FOV: 45 degrees; 2212x1659px — 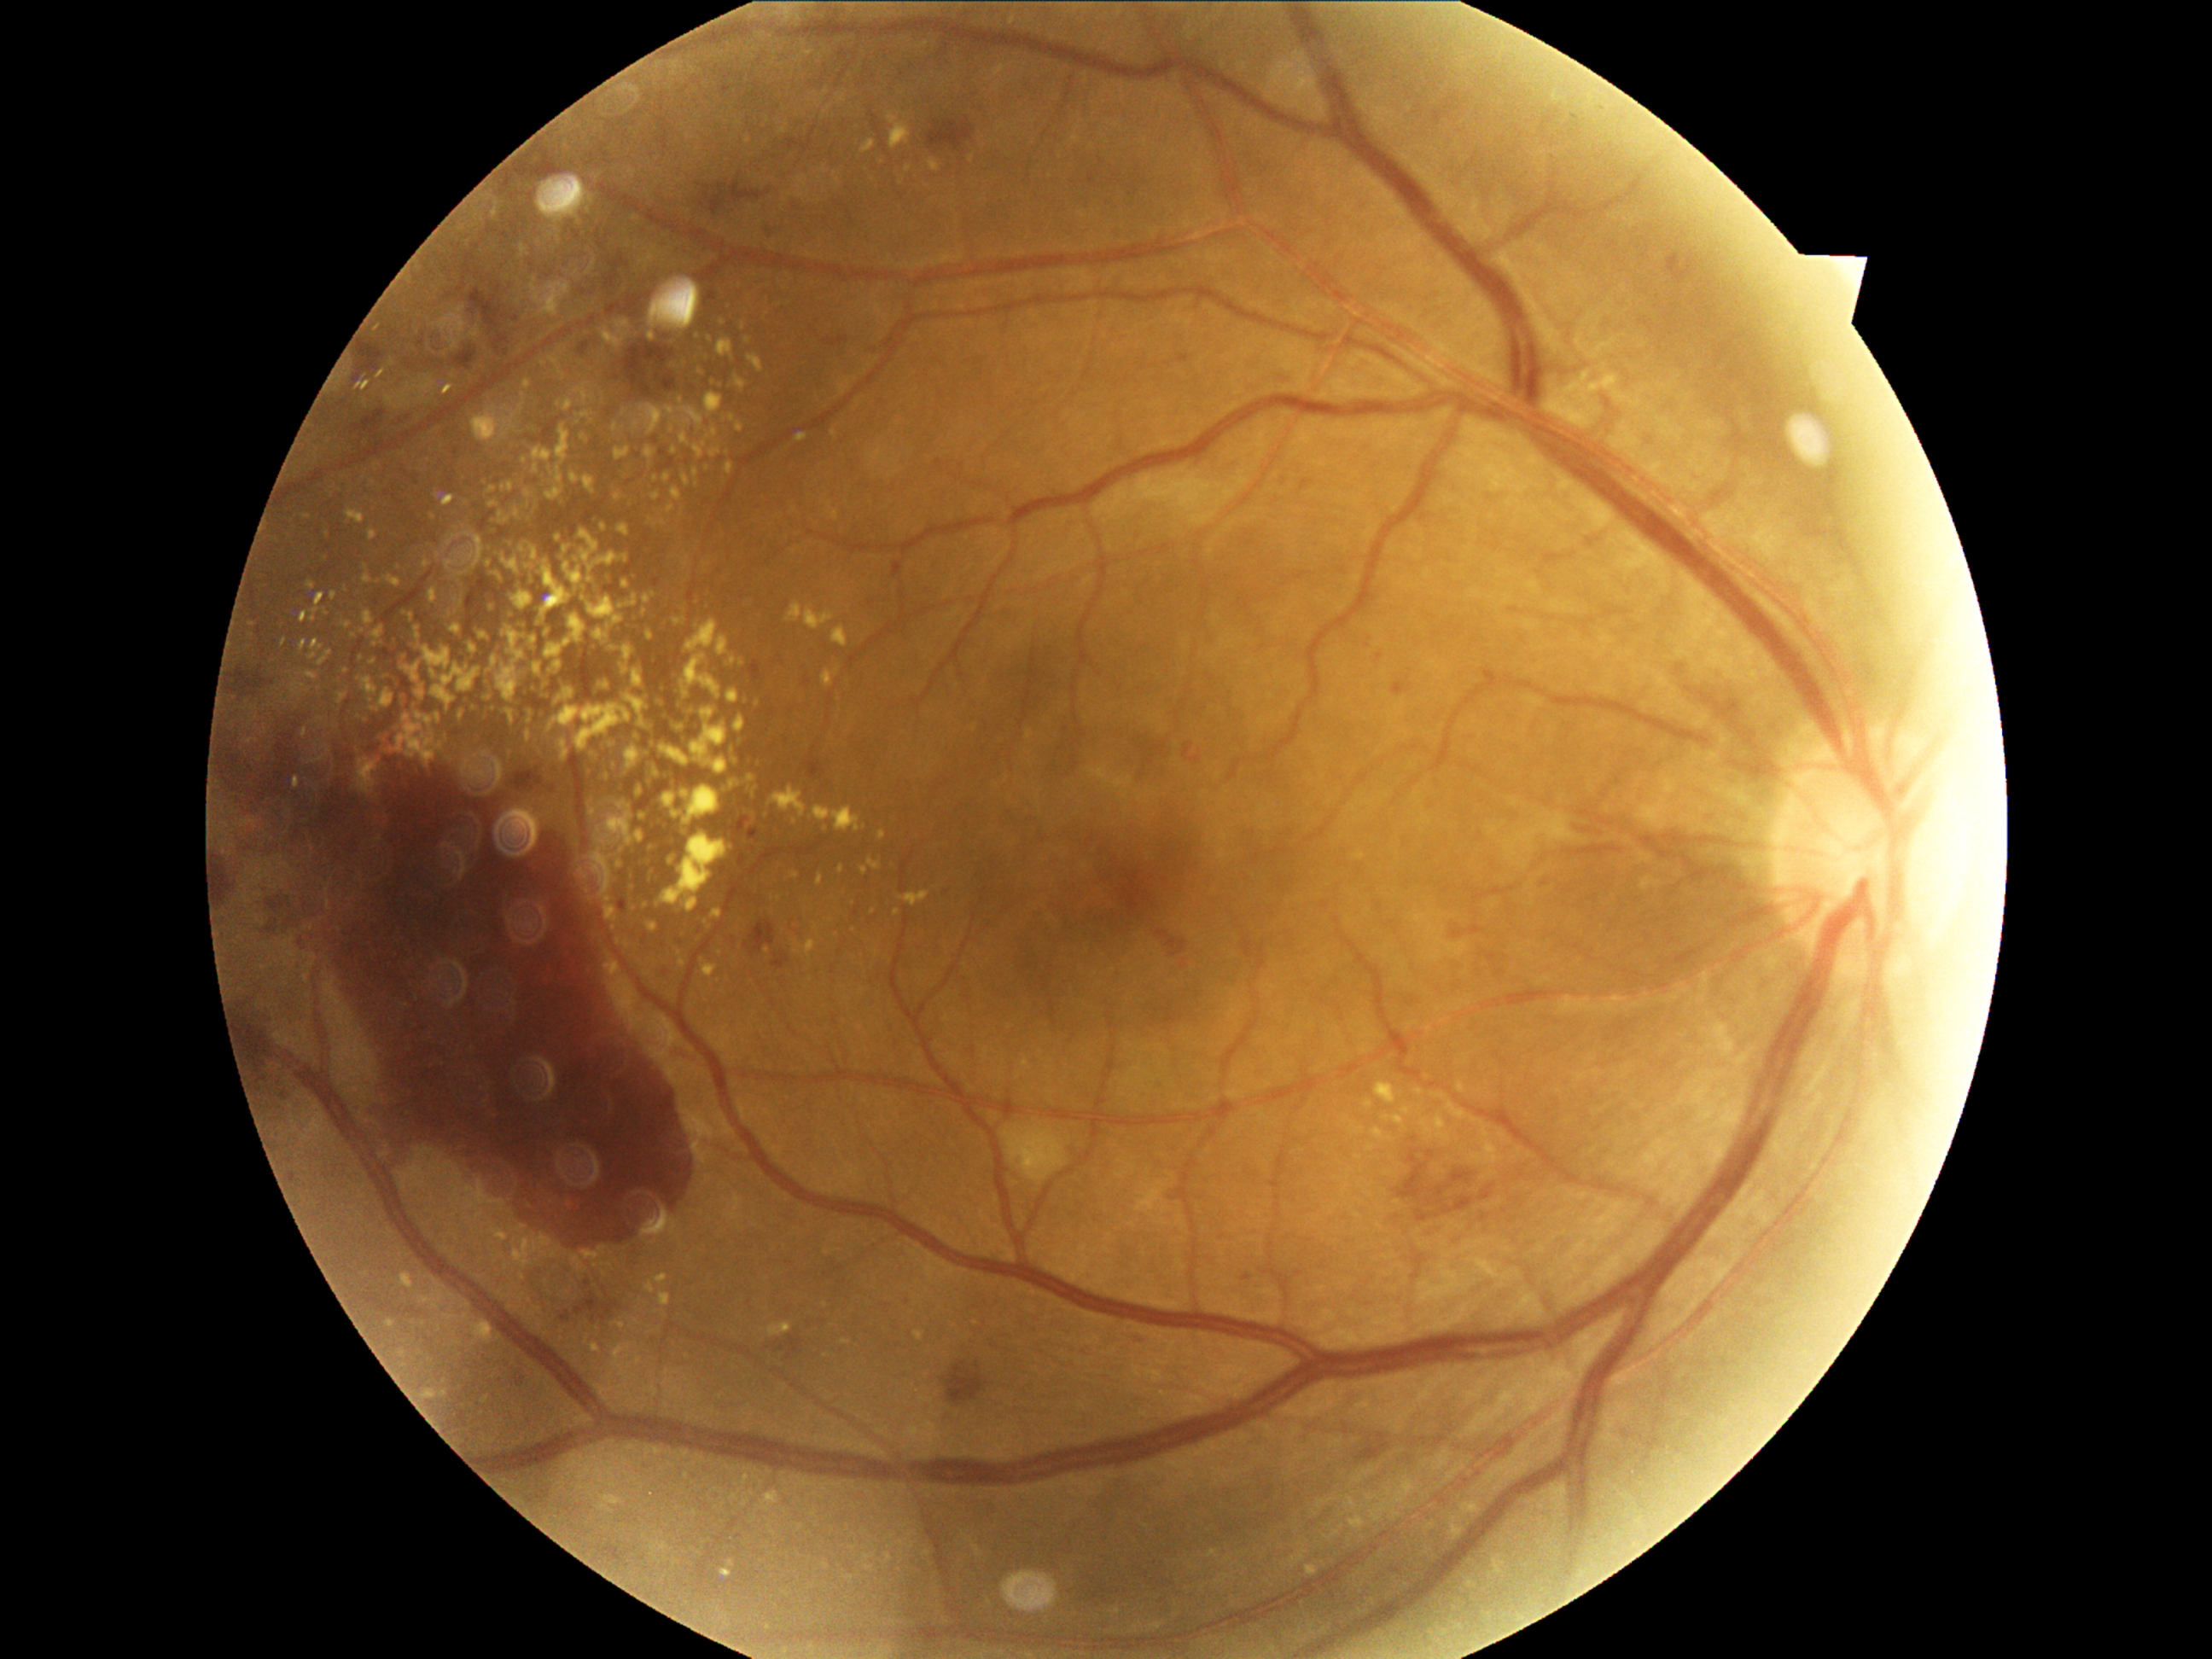

DR stage: grade 4
Selected lesions:
EXs (continued): 929/163/938/172; 610/767/622/772; 706/909/721/926; 646/448/655/458; 1373/1127/1385/1139; 492/515/496/523; 687/620/718/653; 578/390/588/400; 735/716/747/733; 668/407/675/416; 786/16/795/21; 627/696/648/716
Small EXs near [390,1323]; [881,835]; [643,817]; [615,428]; [745,328]; [757,767]; [373,663]